848x848px
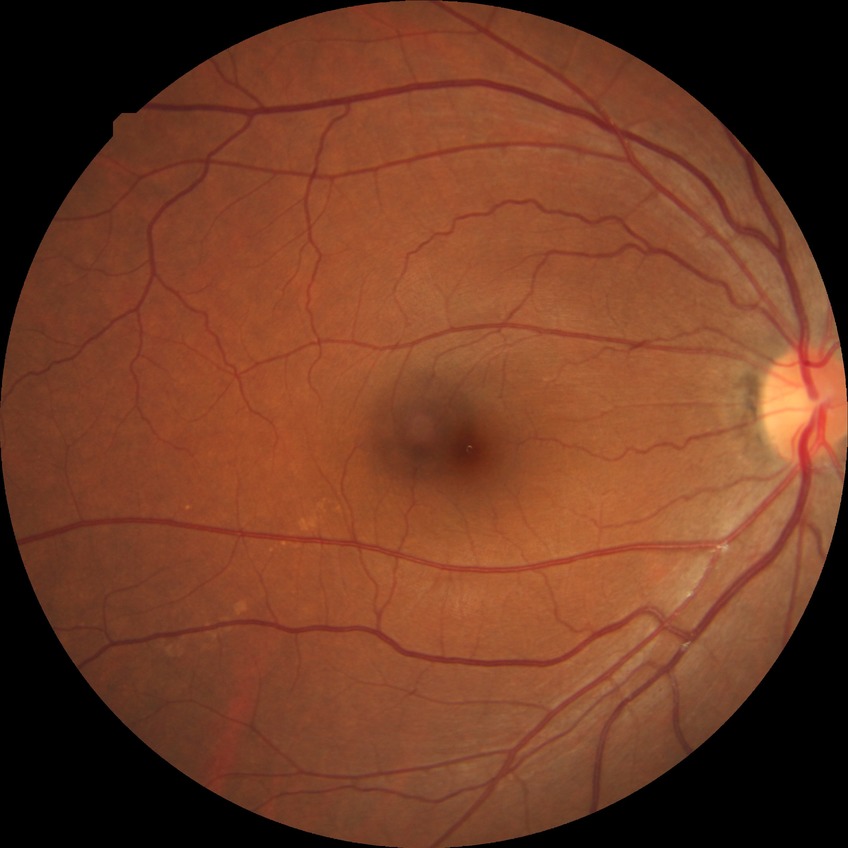 Davis grading: no diabetic retinopathy.